Phoenix ICON, 100° FOV; 1240 by 1240 pixels; infant wide-field retinal image
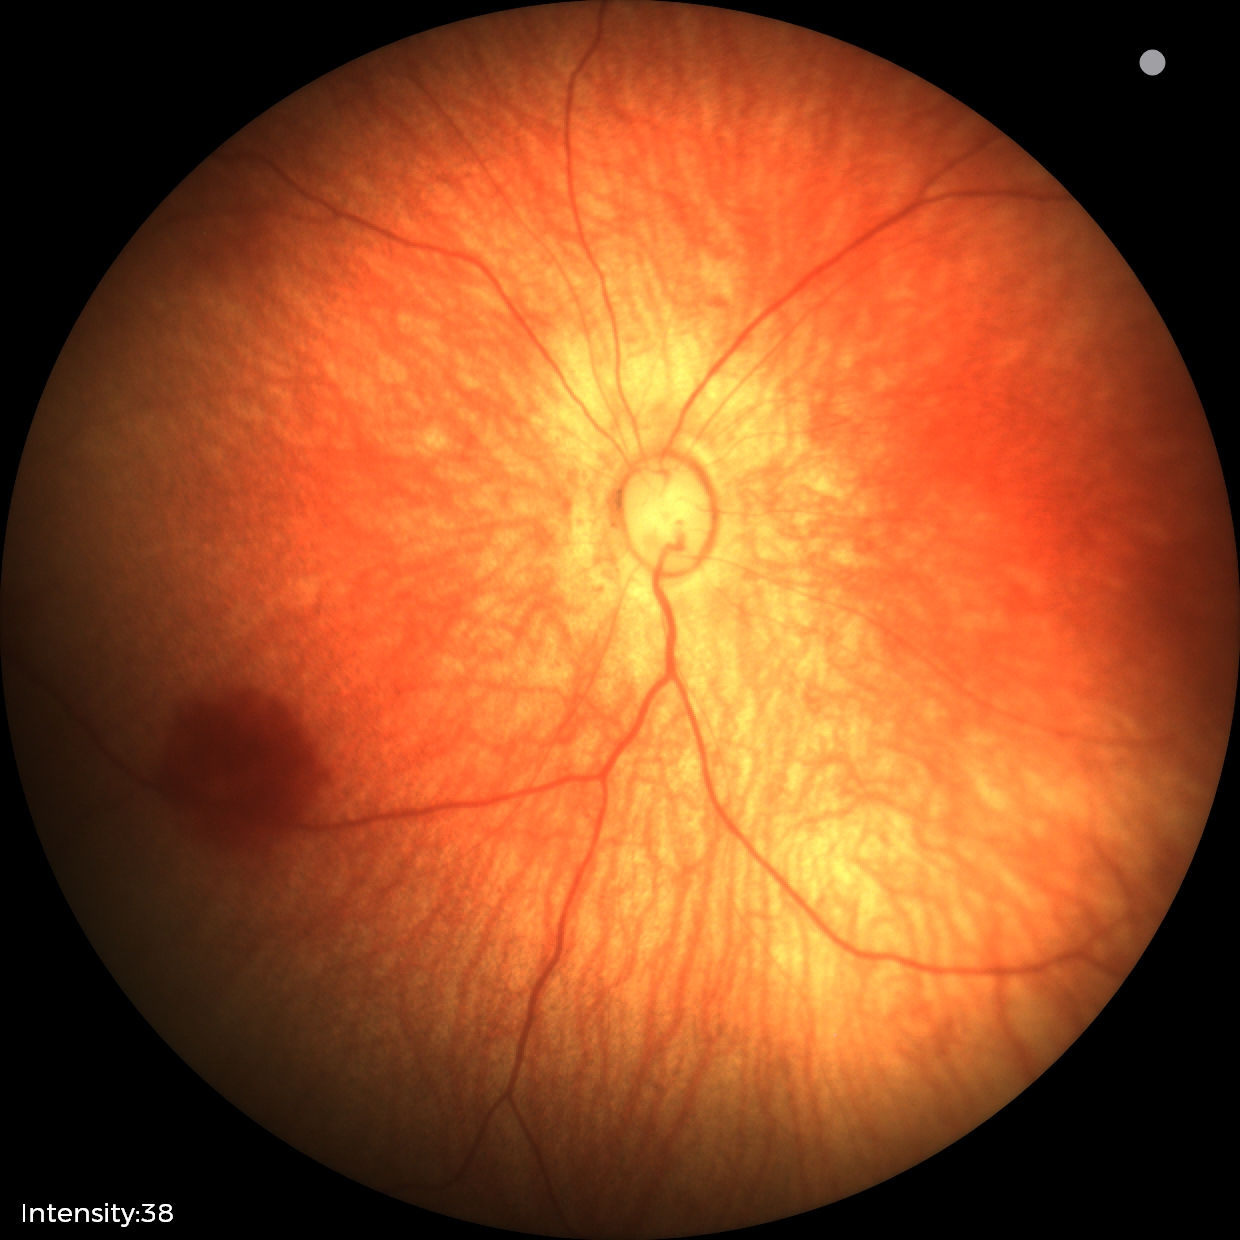

Impression = physiological